45° field of view, color fundus image, image size 2352x1568: 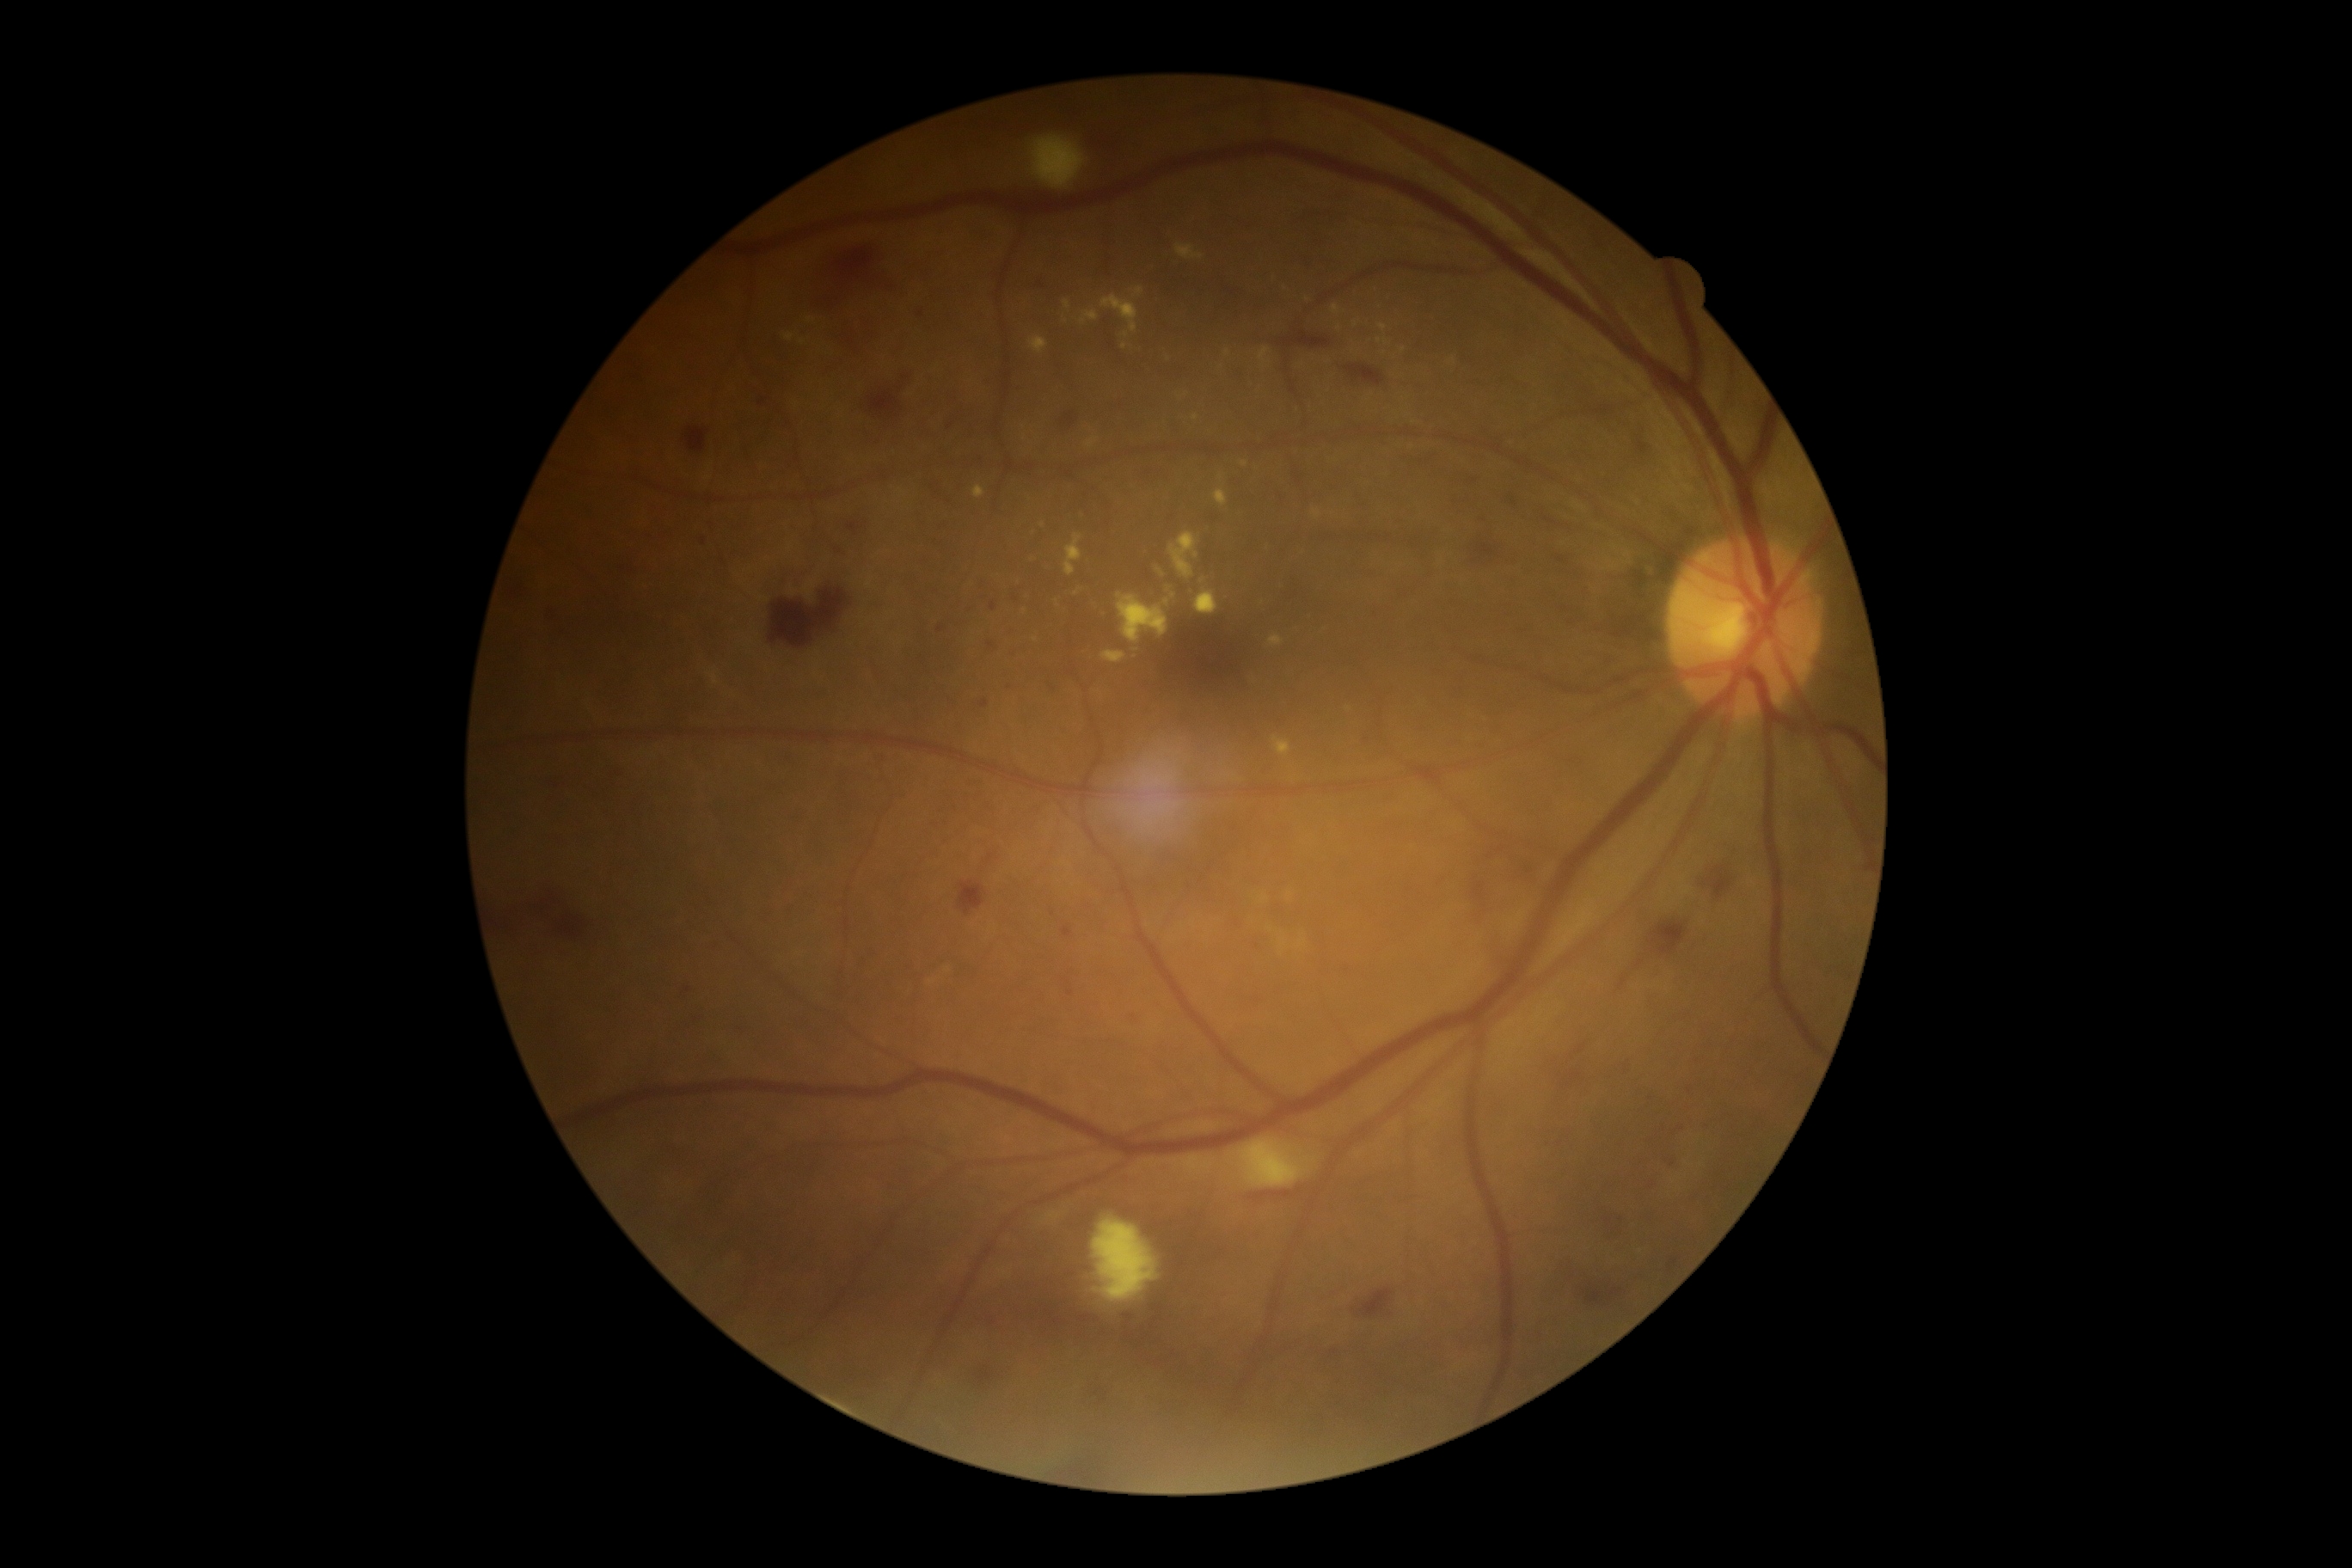
Diabetic retinopathy (DR) is grade 2 (moderate NPDR) — more than just microaneurysms but less than severe NPDR.